Fundus photo: 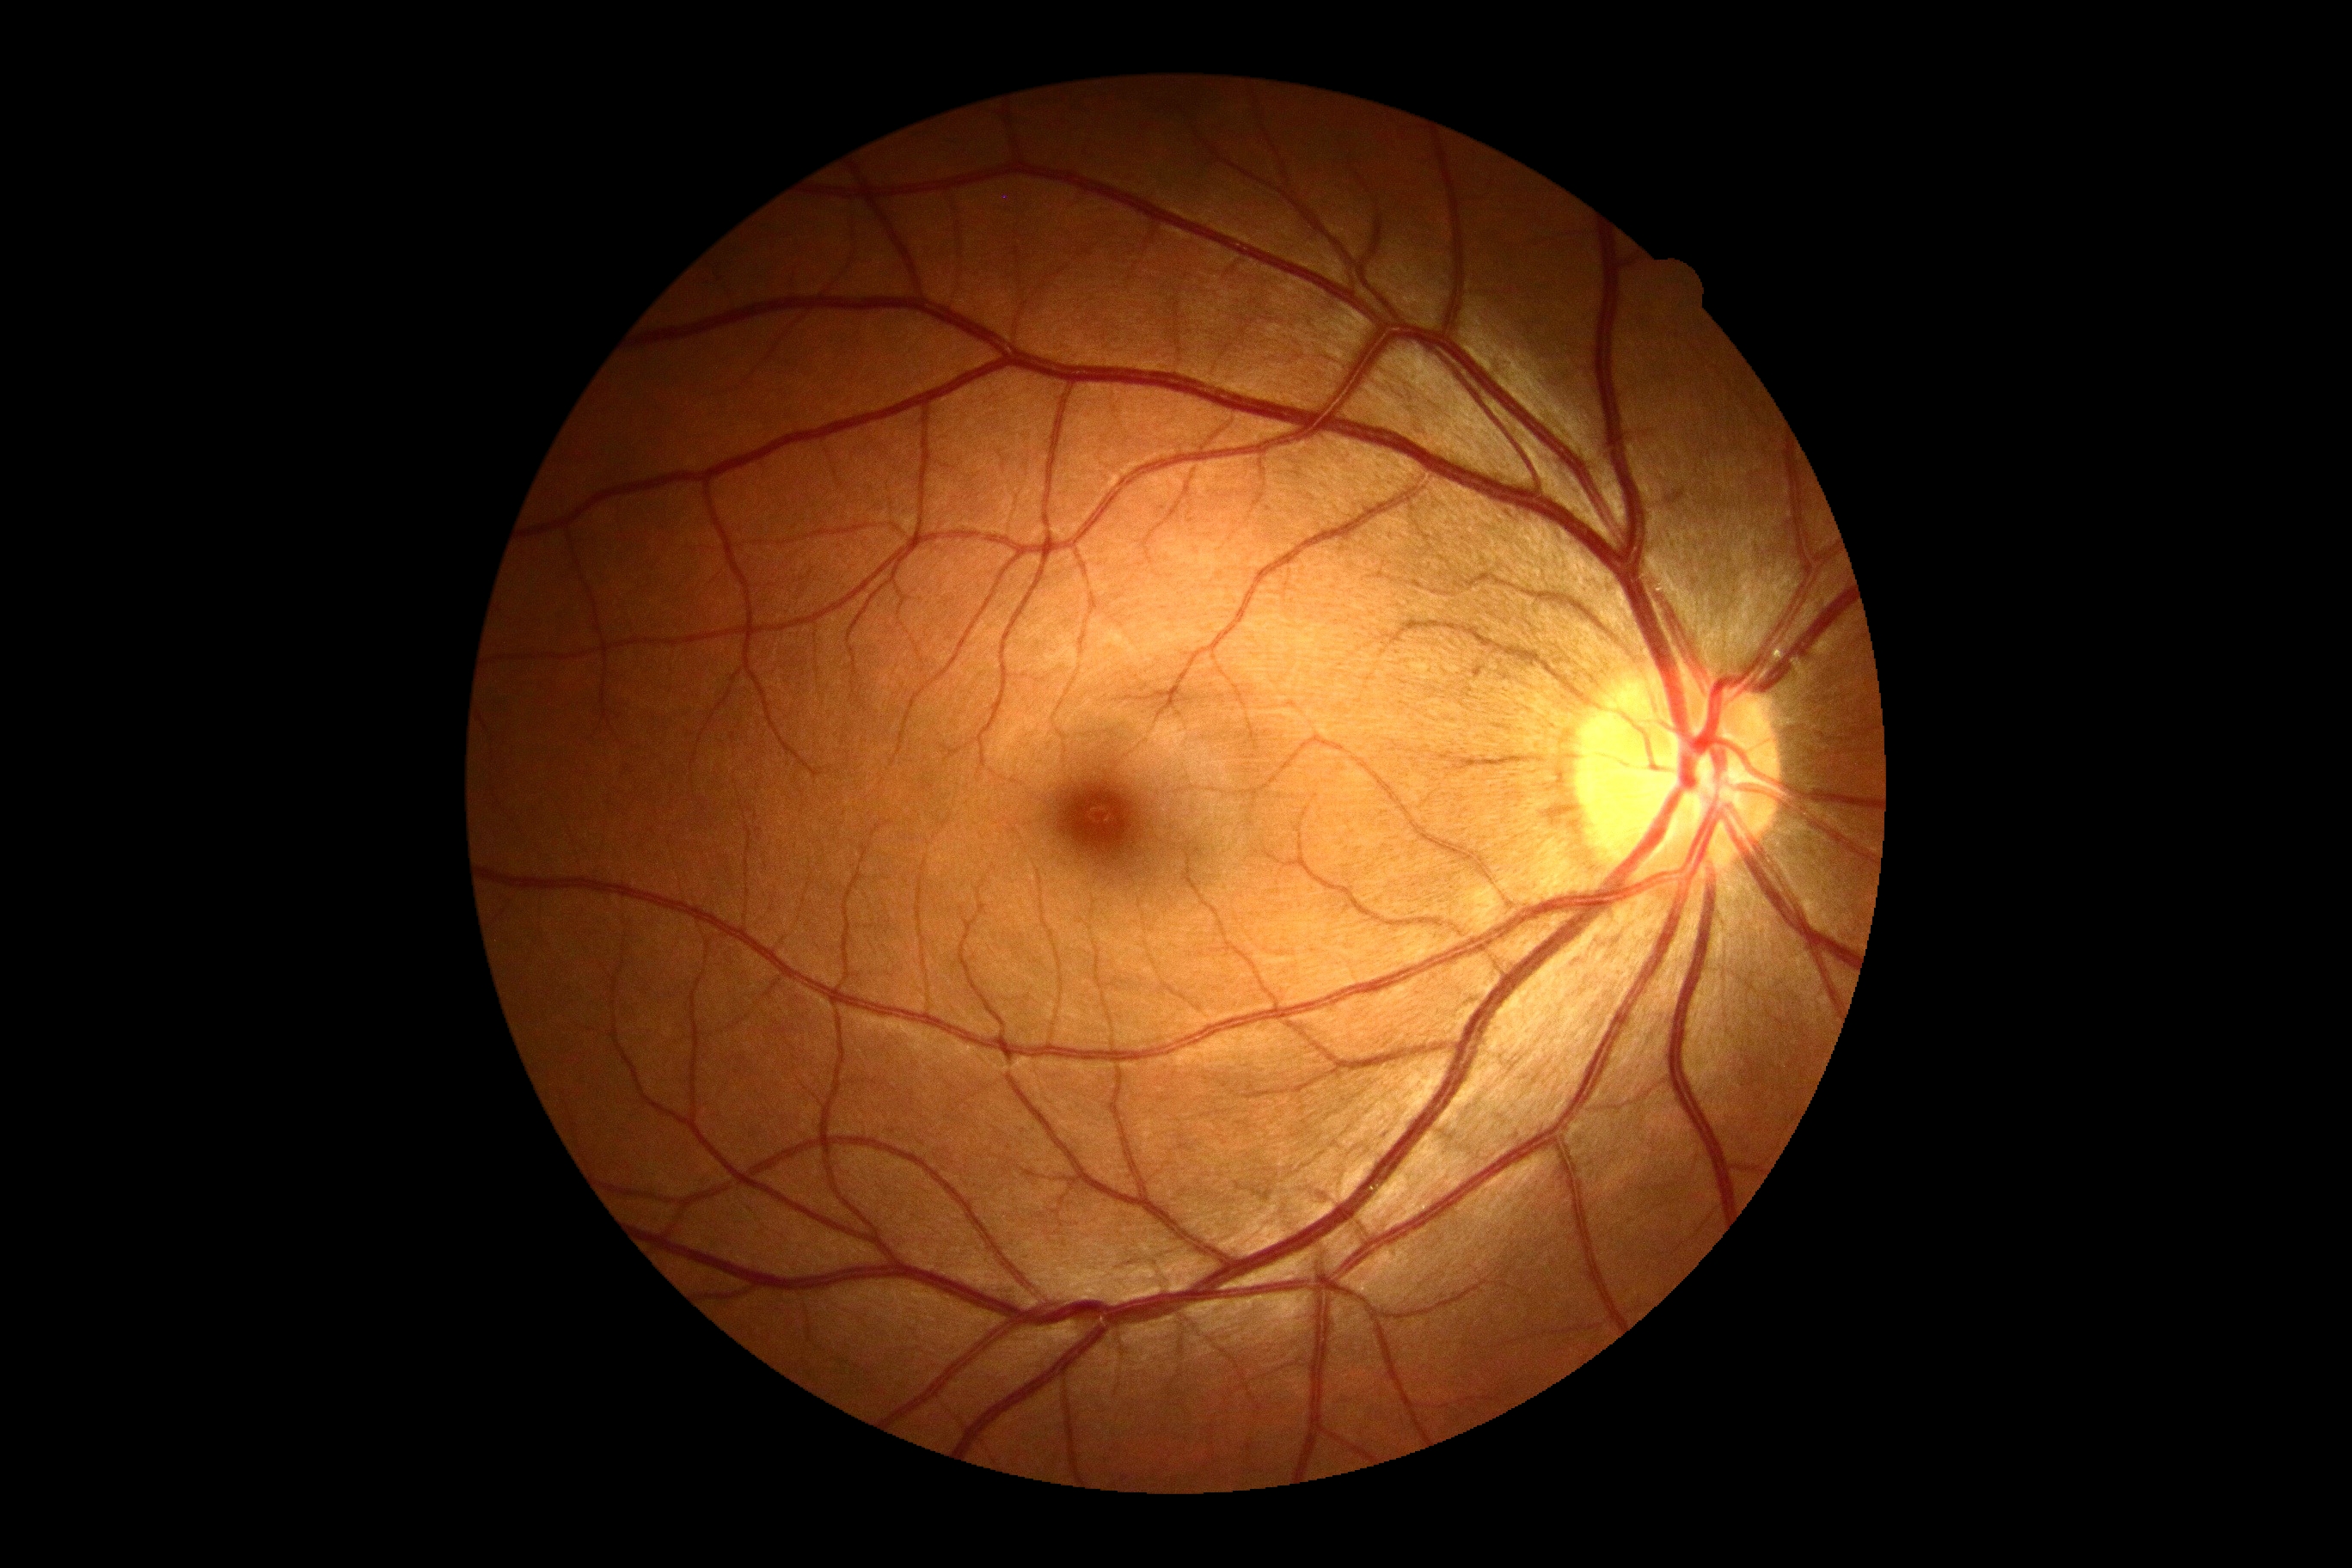 DR severity: grade 0.